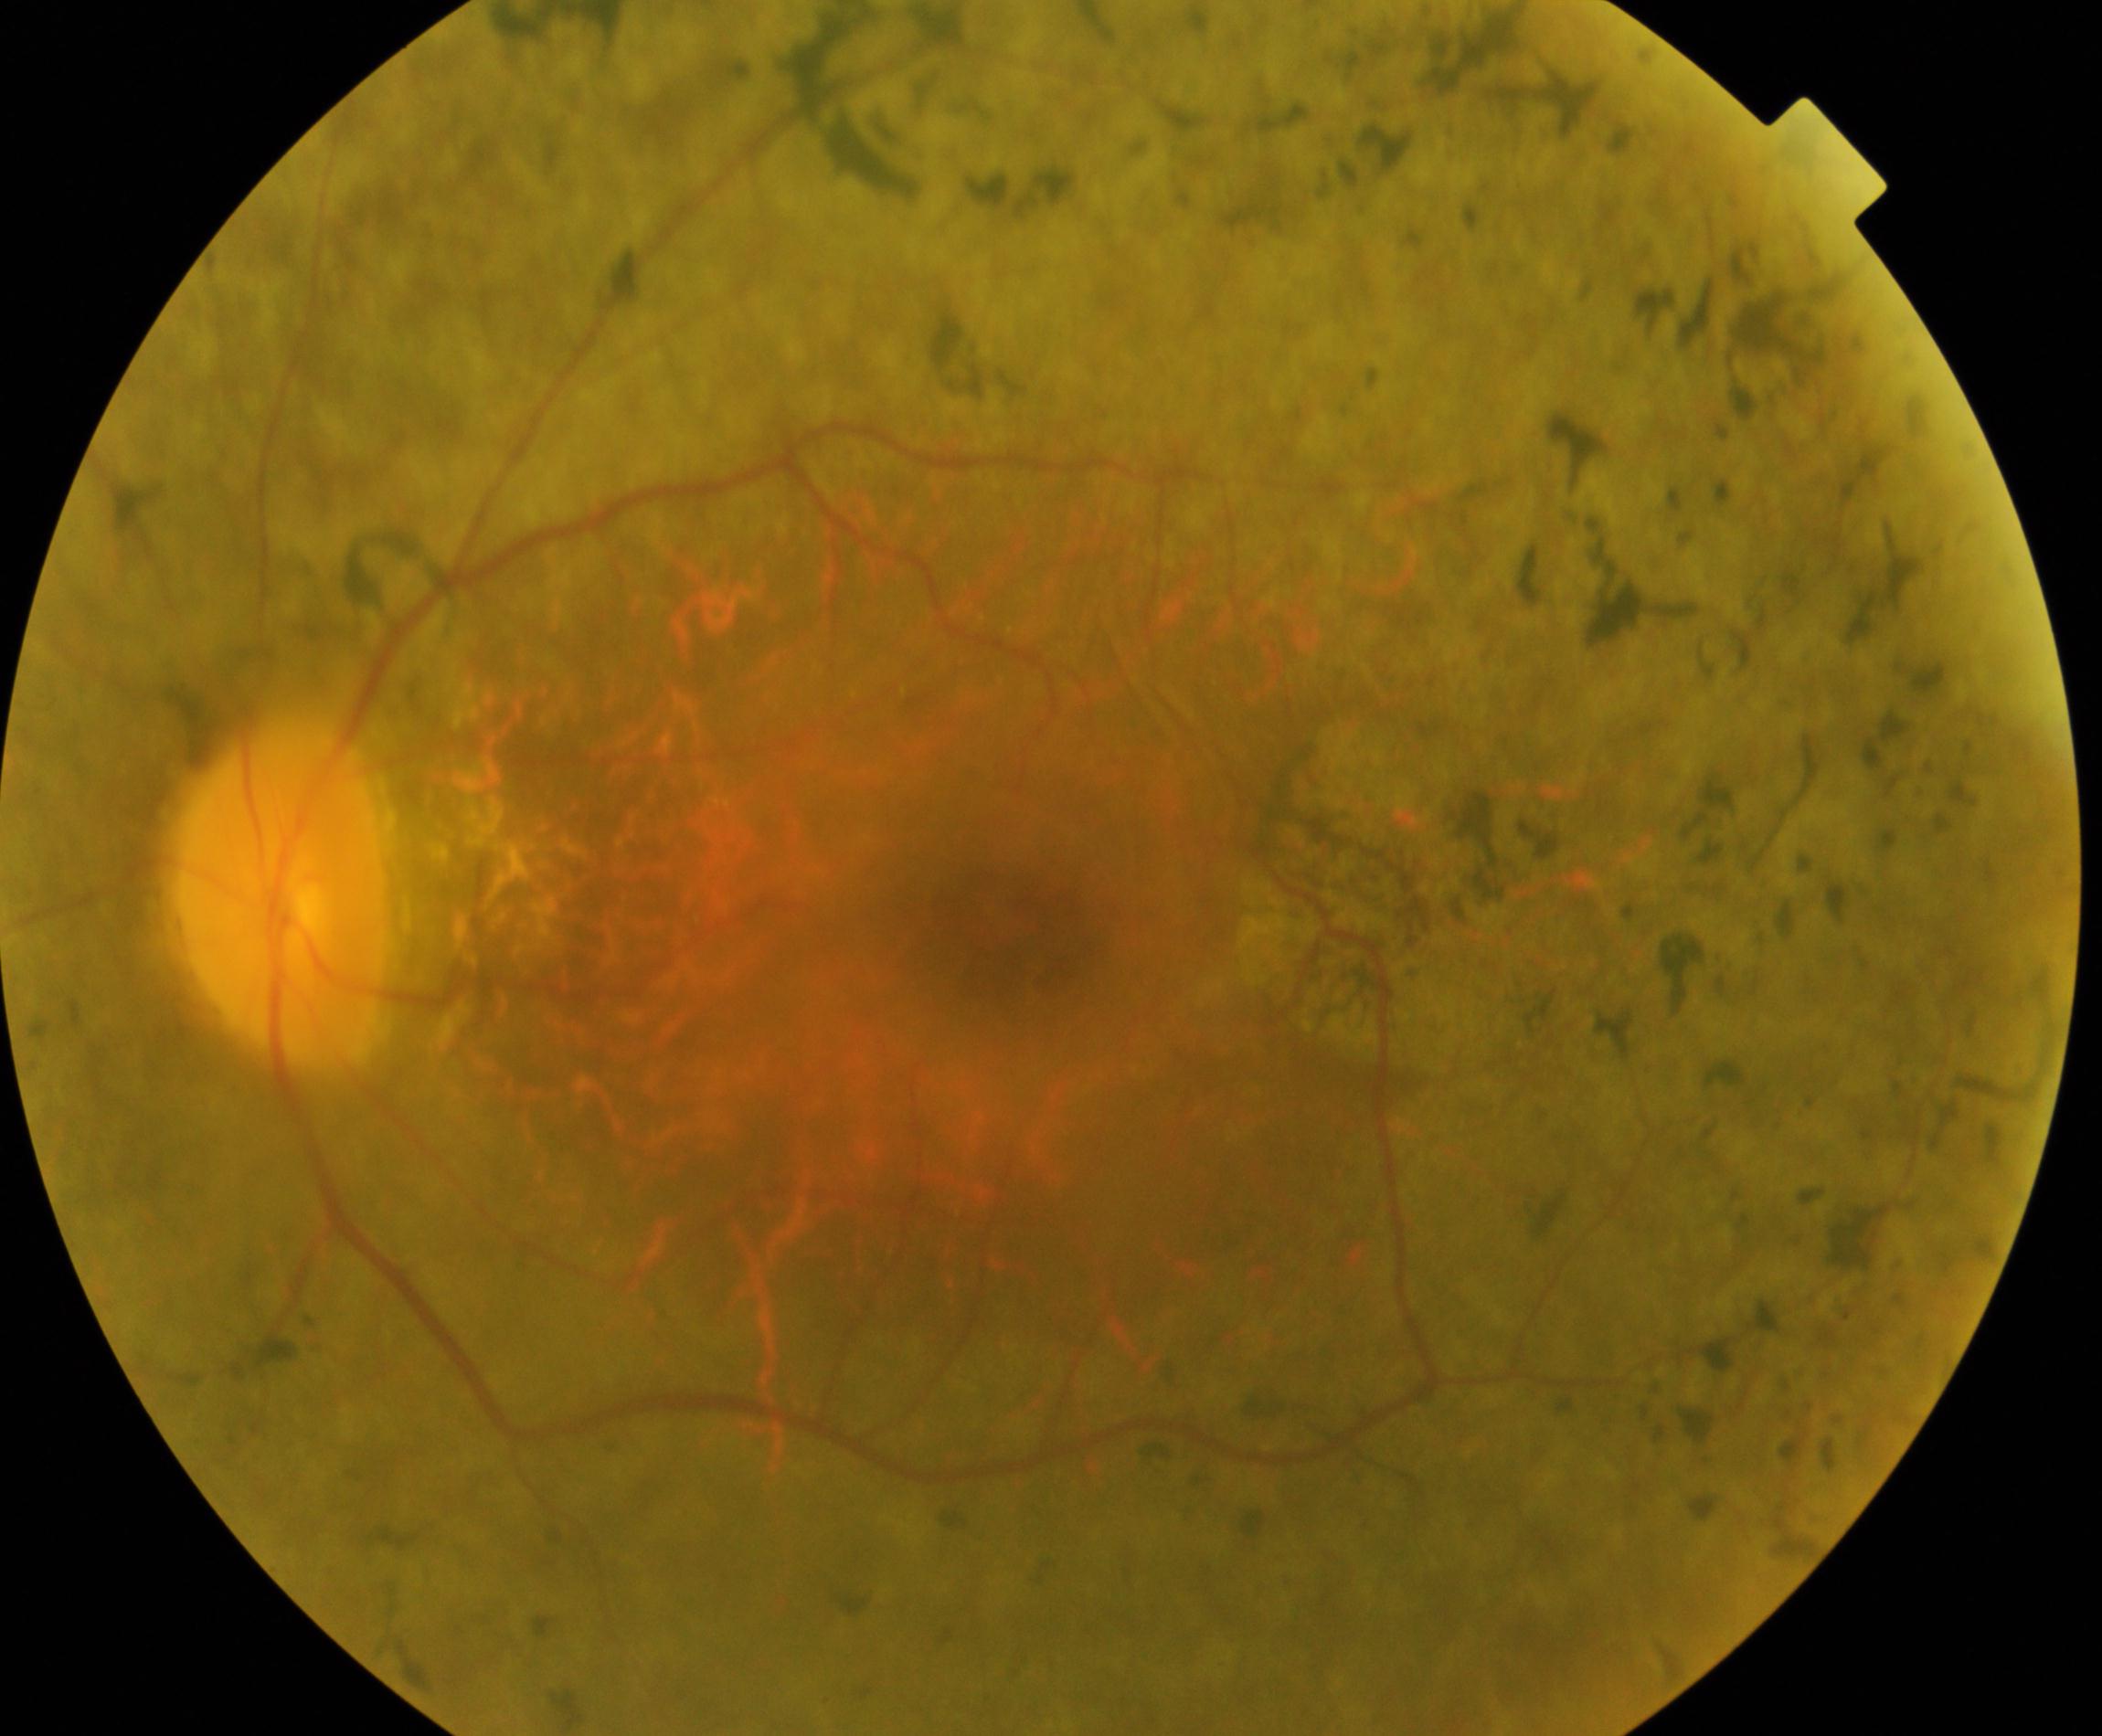

Color fundus photograph showing retinitis pigmentosa. Defined by mid-peripheral retinal pigment epithelium atrophy with bone-spicule perivascular pigmentation, arteriolar attenuation, and waxy disc pallor.